45-degree field of view. Diabetic retinopathy graded by the modified Davis classification.
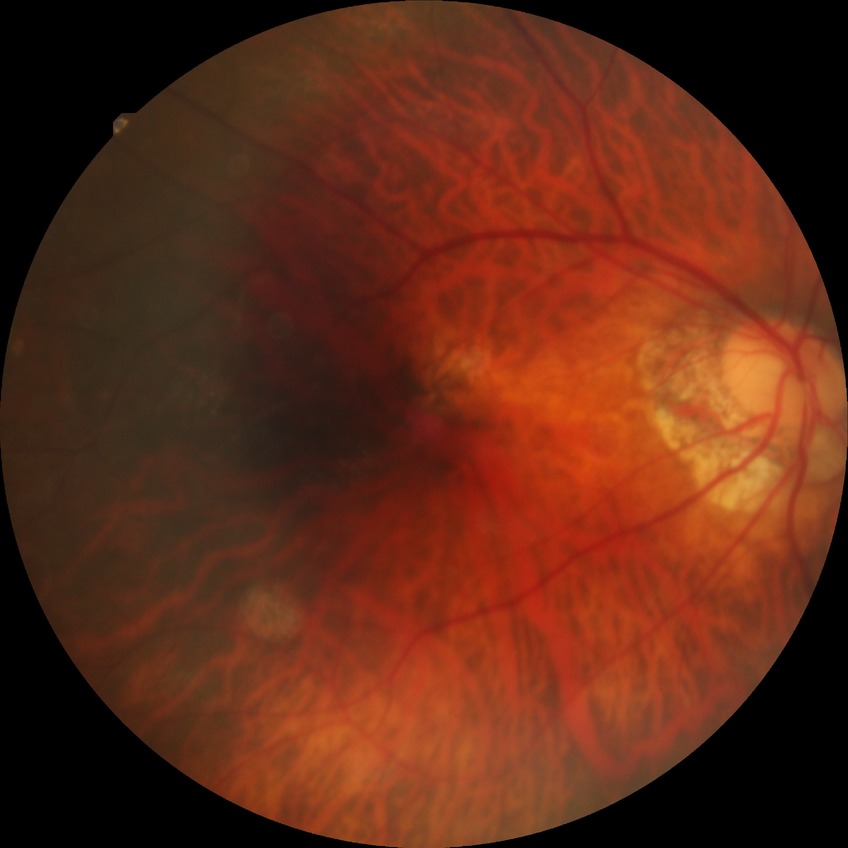
Diabetic retinopathy (DR) is SDR (simple diabetic retinopathy).